Nonmydriatic fundus photograph · image size 848x848 · camera: NIDEK AFC-230 · modified Davis classification · 45° field of view · color fundus image — 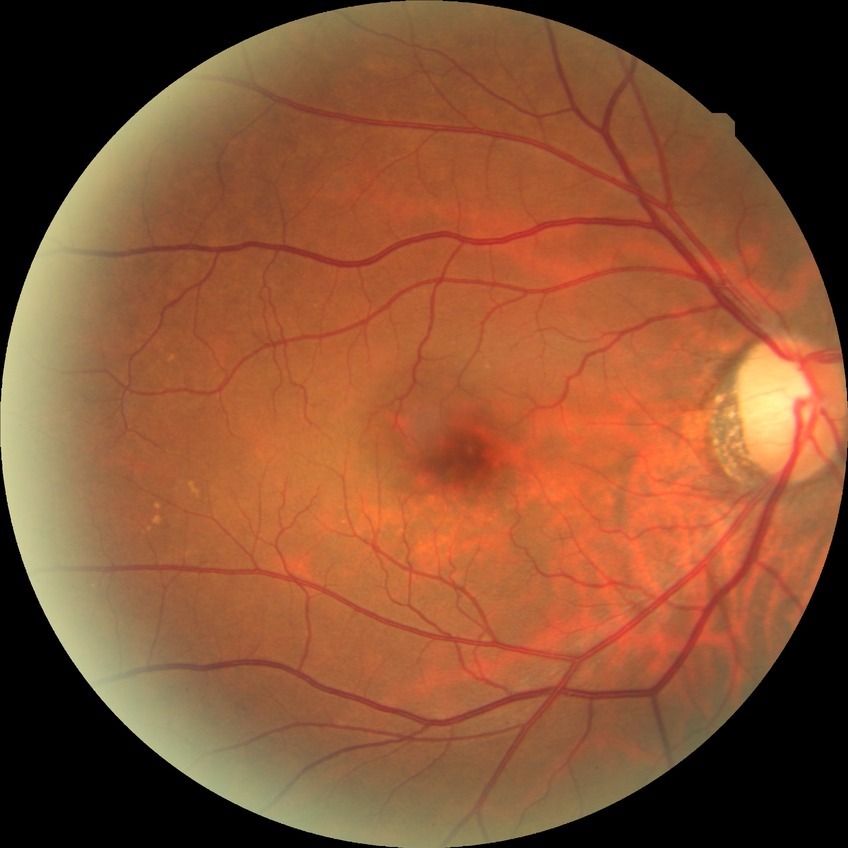
modified Davis grading = no diabetic retinopathy.